Modified Davis classification; 45° field of view
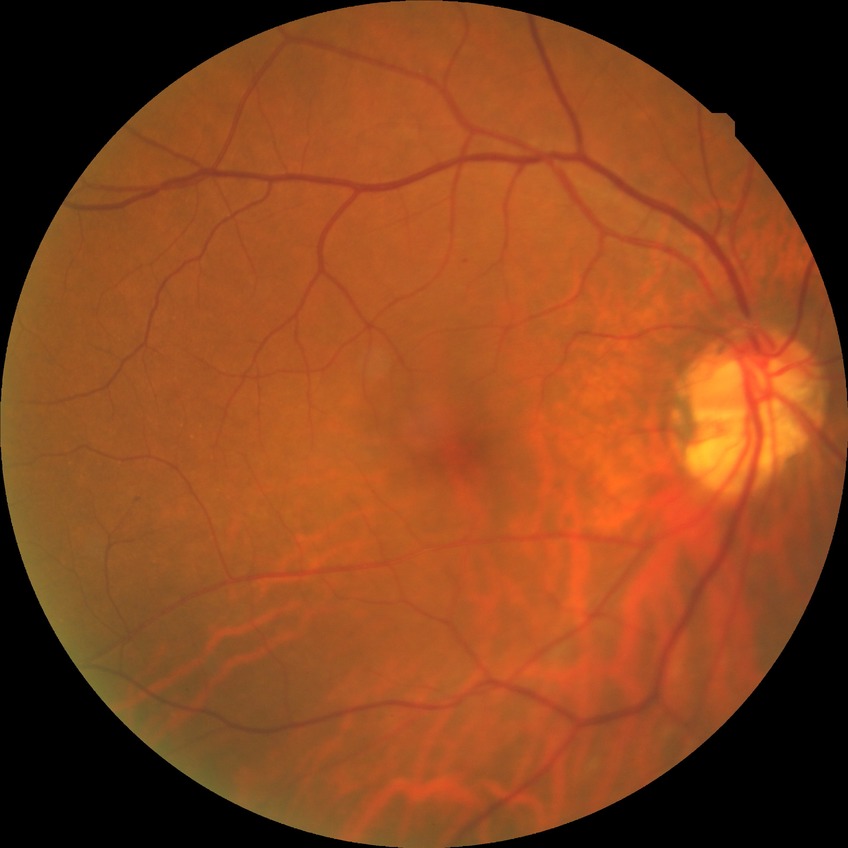
diabetic retinopathy (DR): no diabetic retinopathy (NDR)